CFP; 848x848px; camera: NIDEK AFC-230; 45-degree field of view
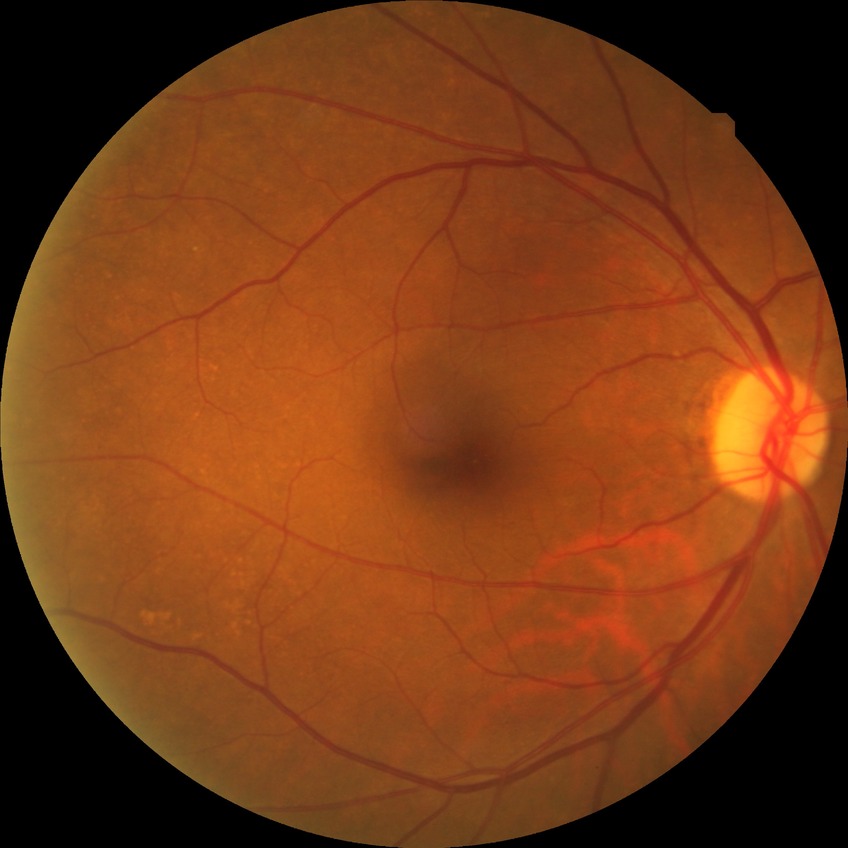 Diabetic retinopathy severity is no diabetic retinopathy.